1536x1152px. 45° field of view.
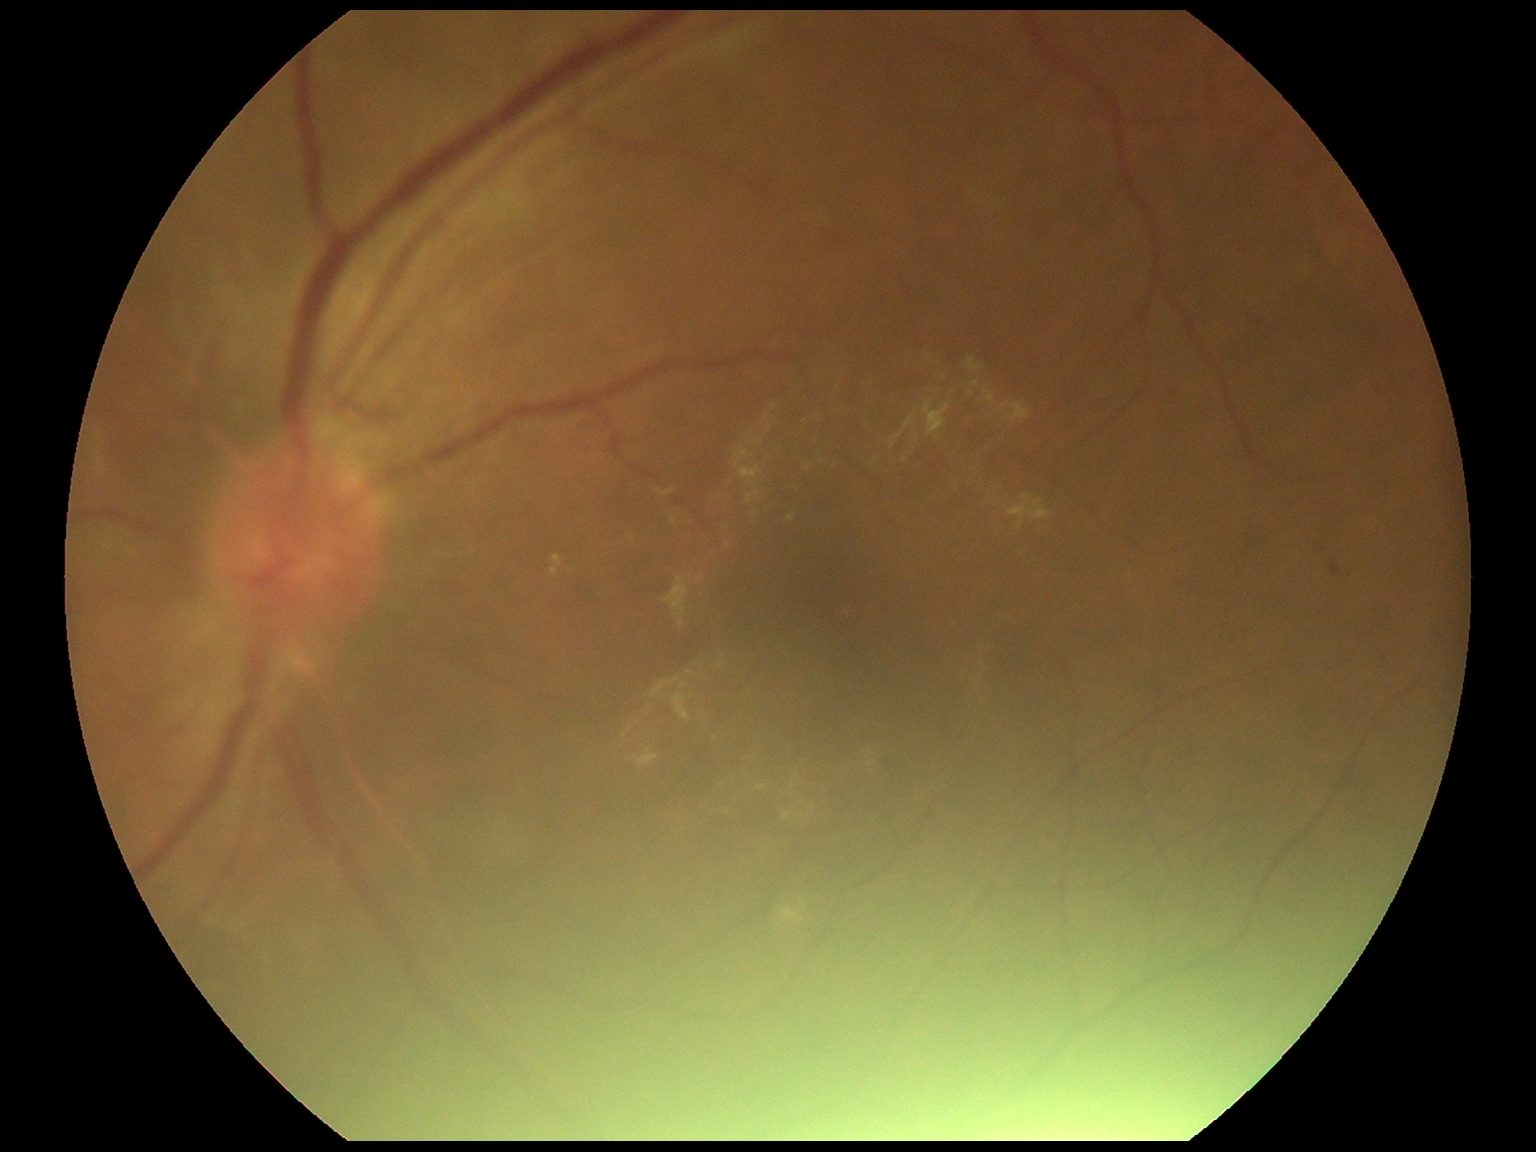
DR stage: grade 1 (mild NPDR)